2352 by 1568 pixels; 45° field of view:
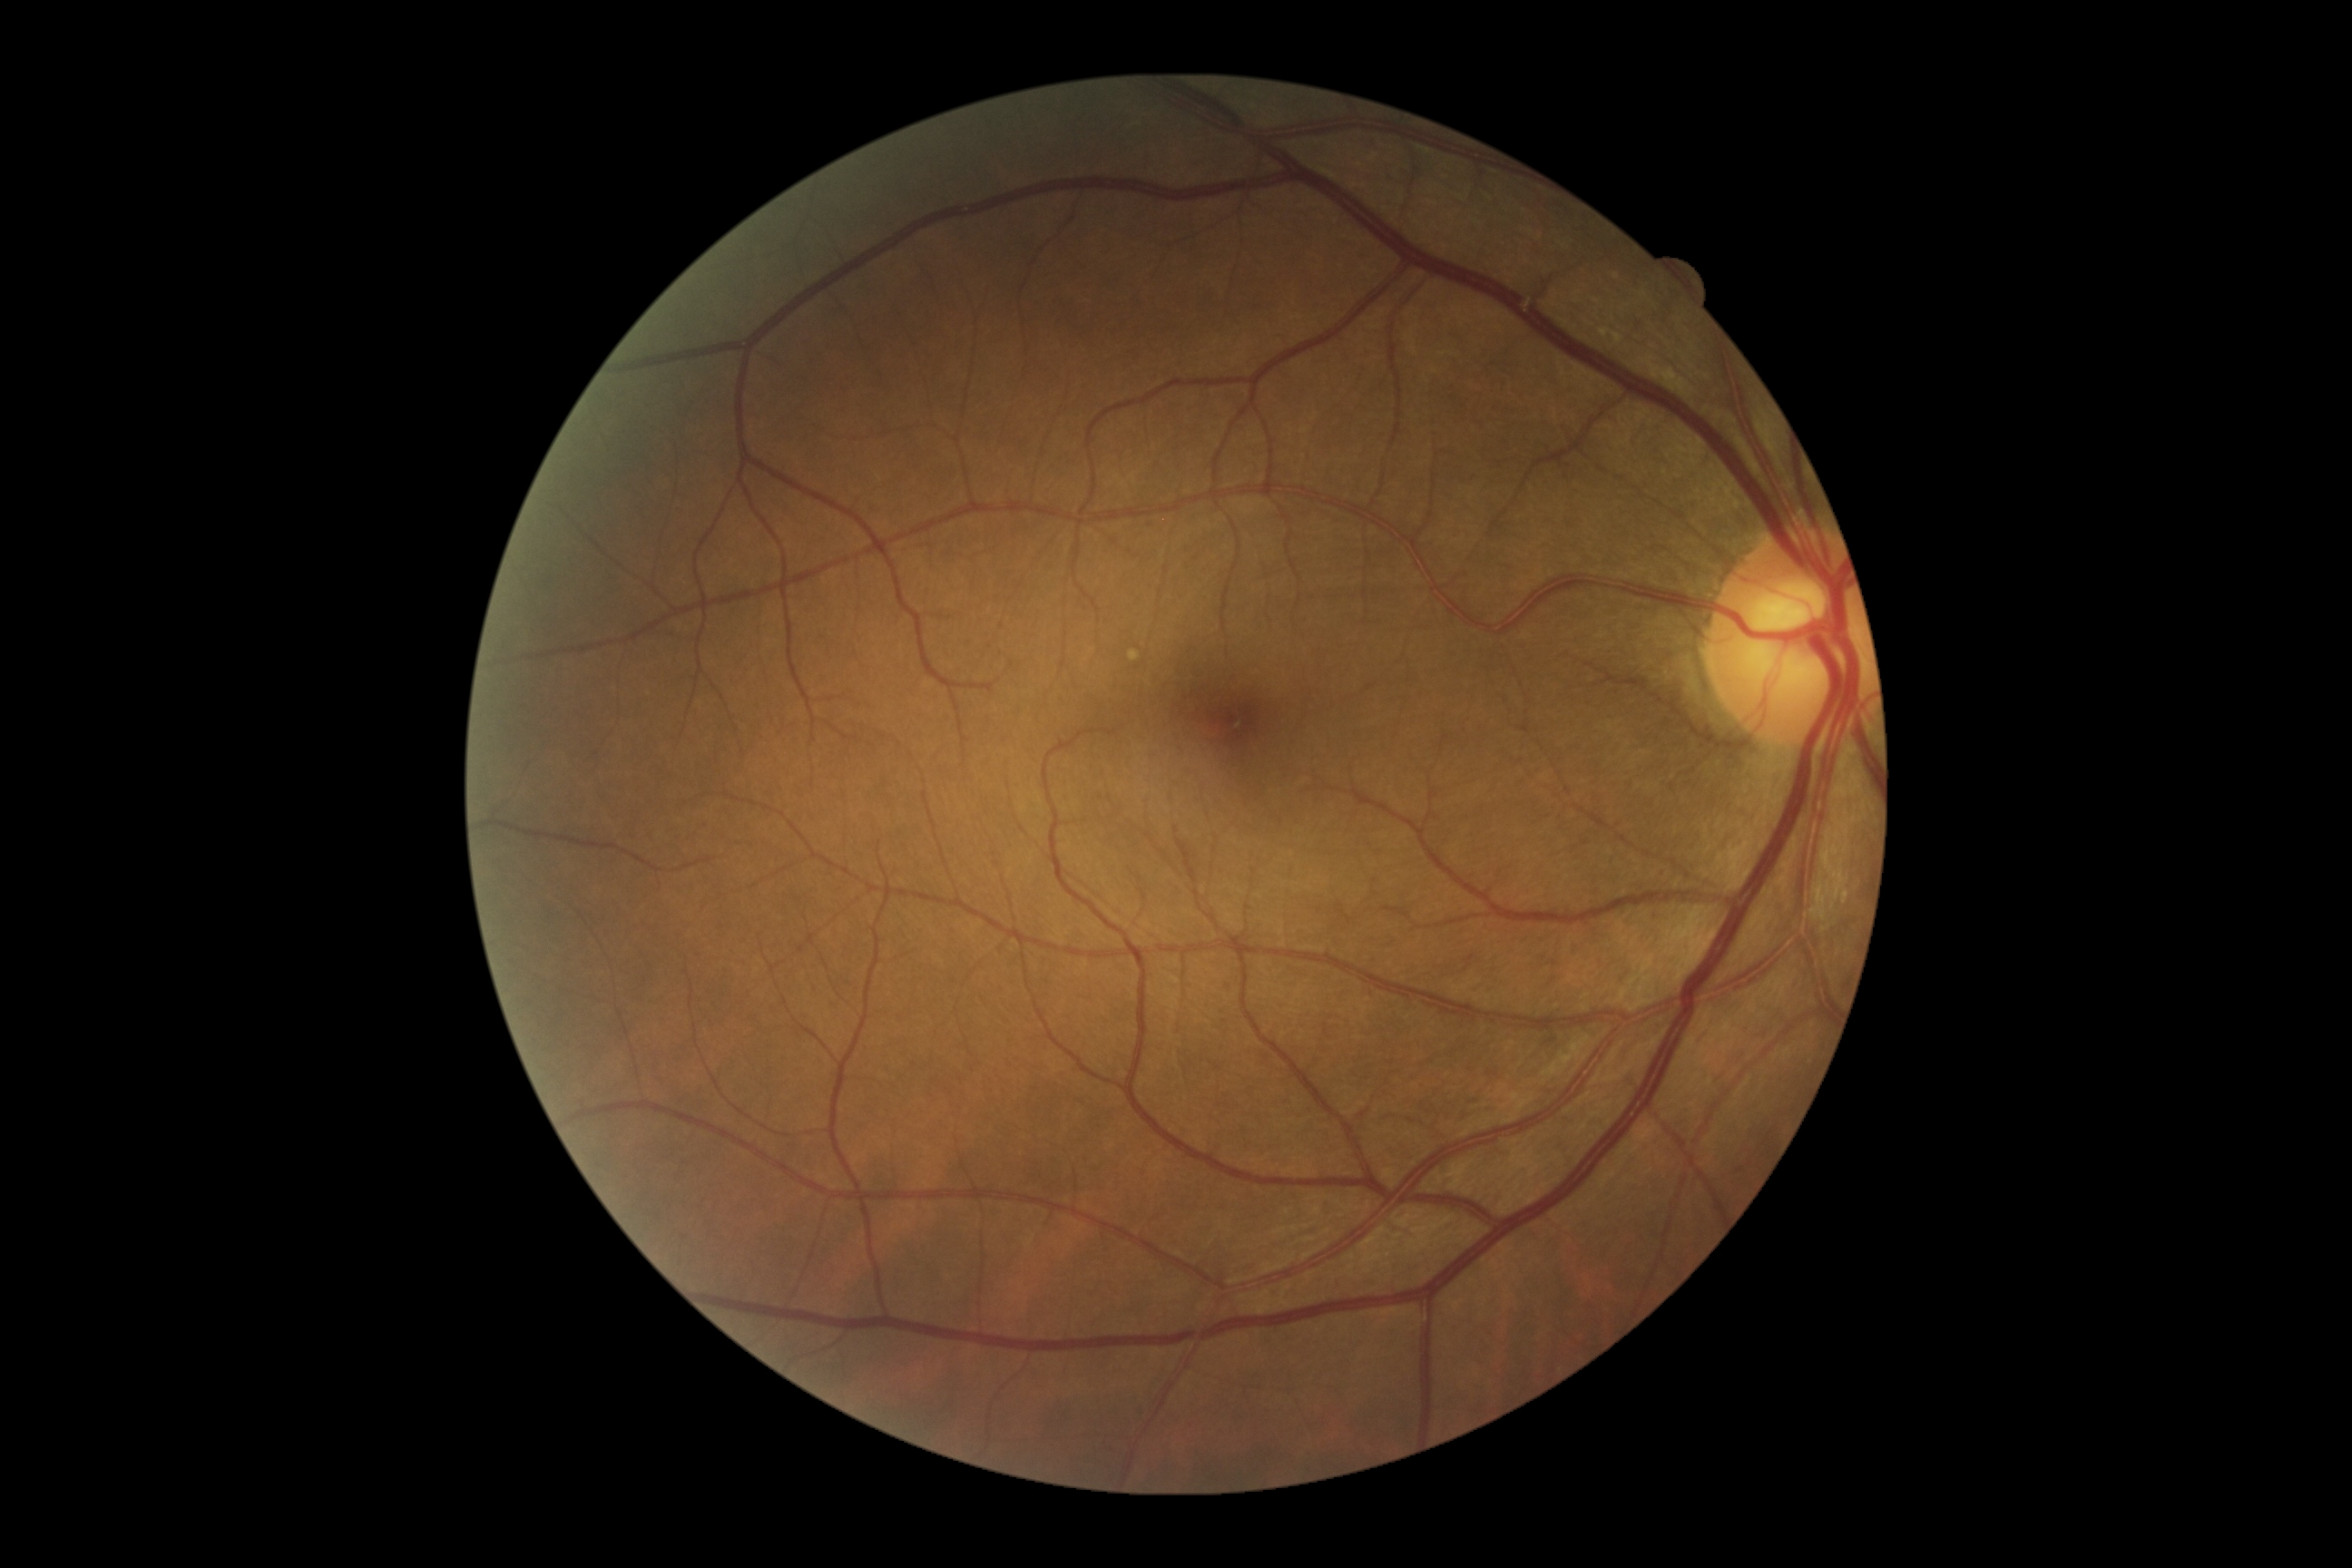 DR impression: no DR findings, DR grade: 0 (no apparent retinopathy).